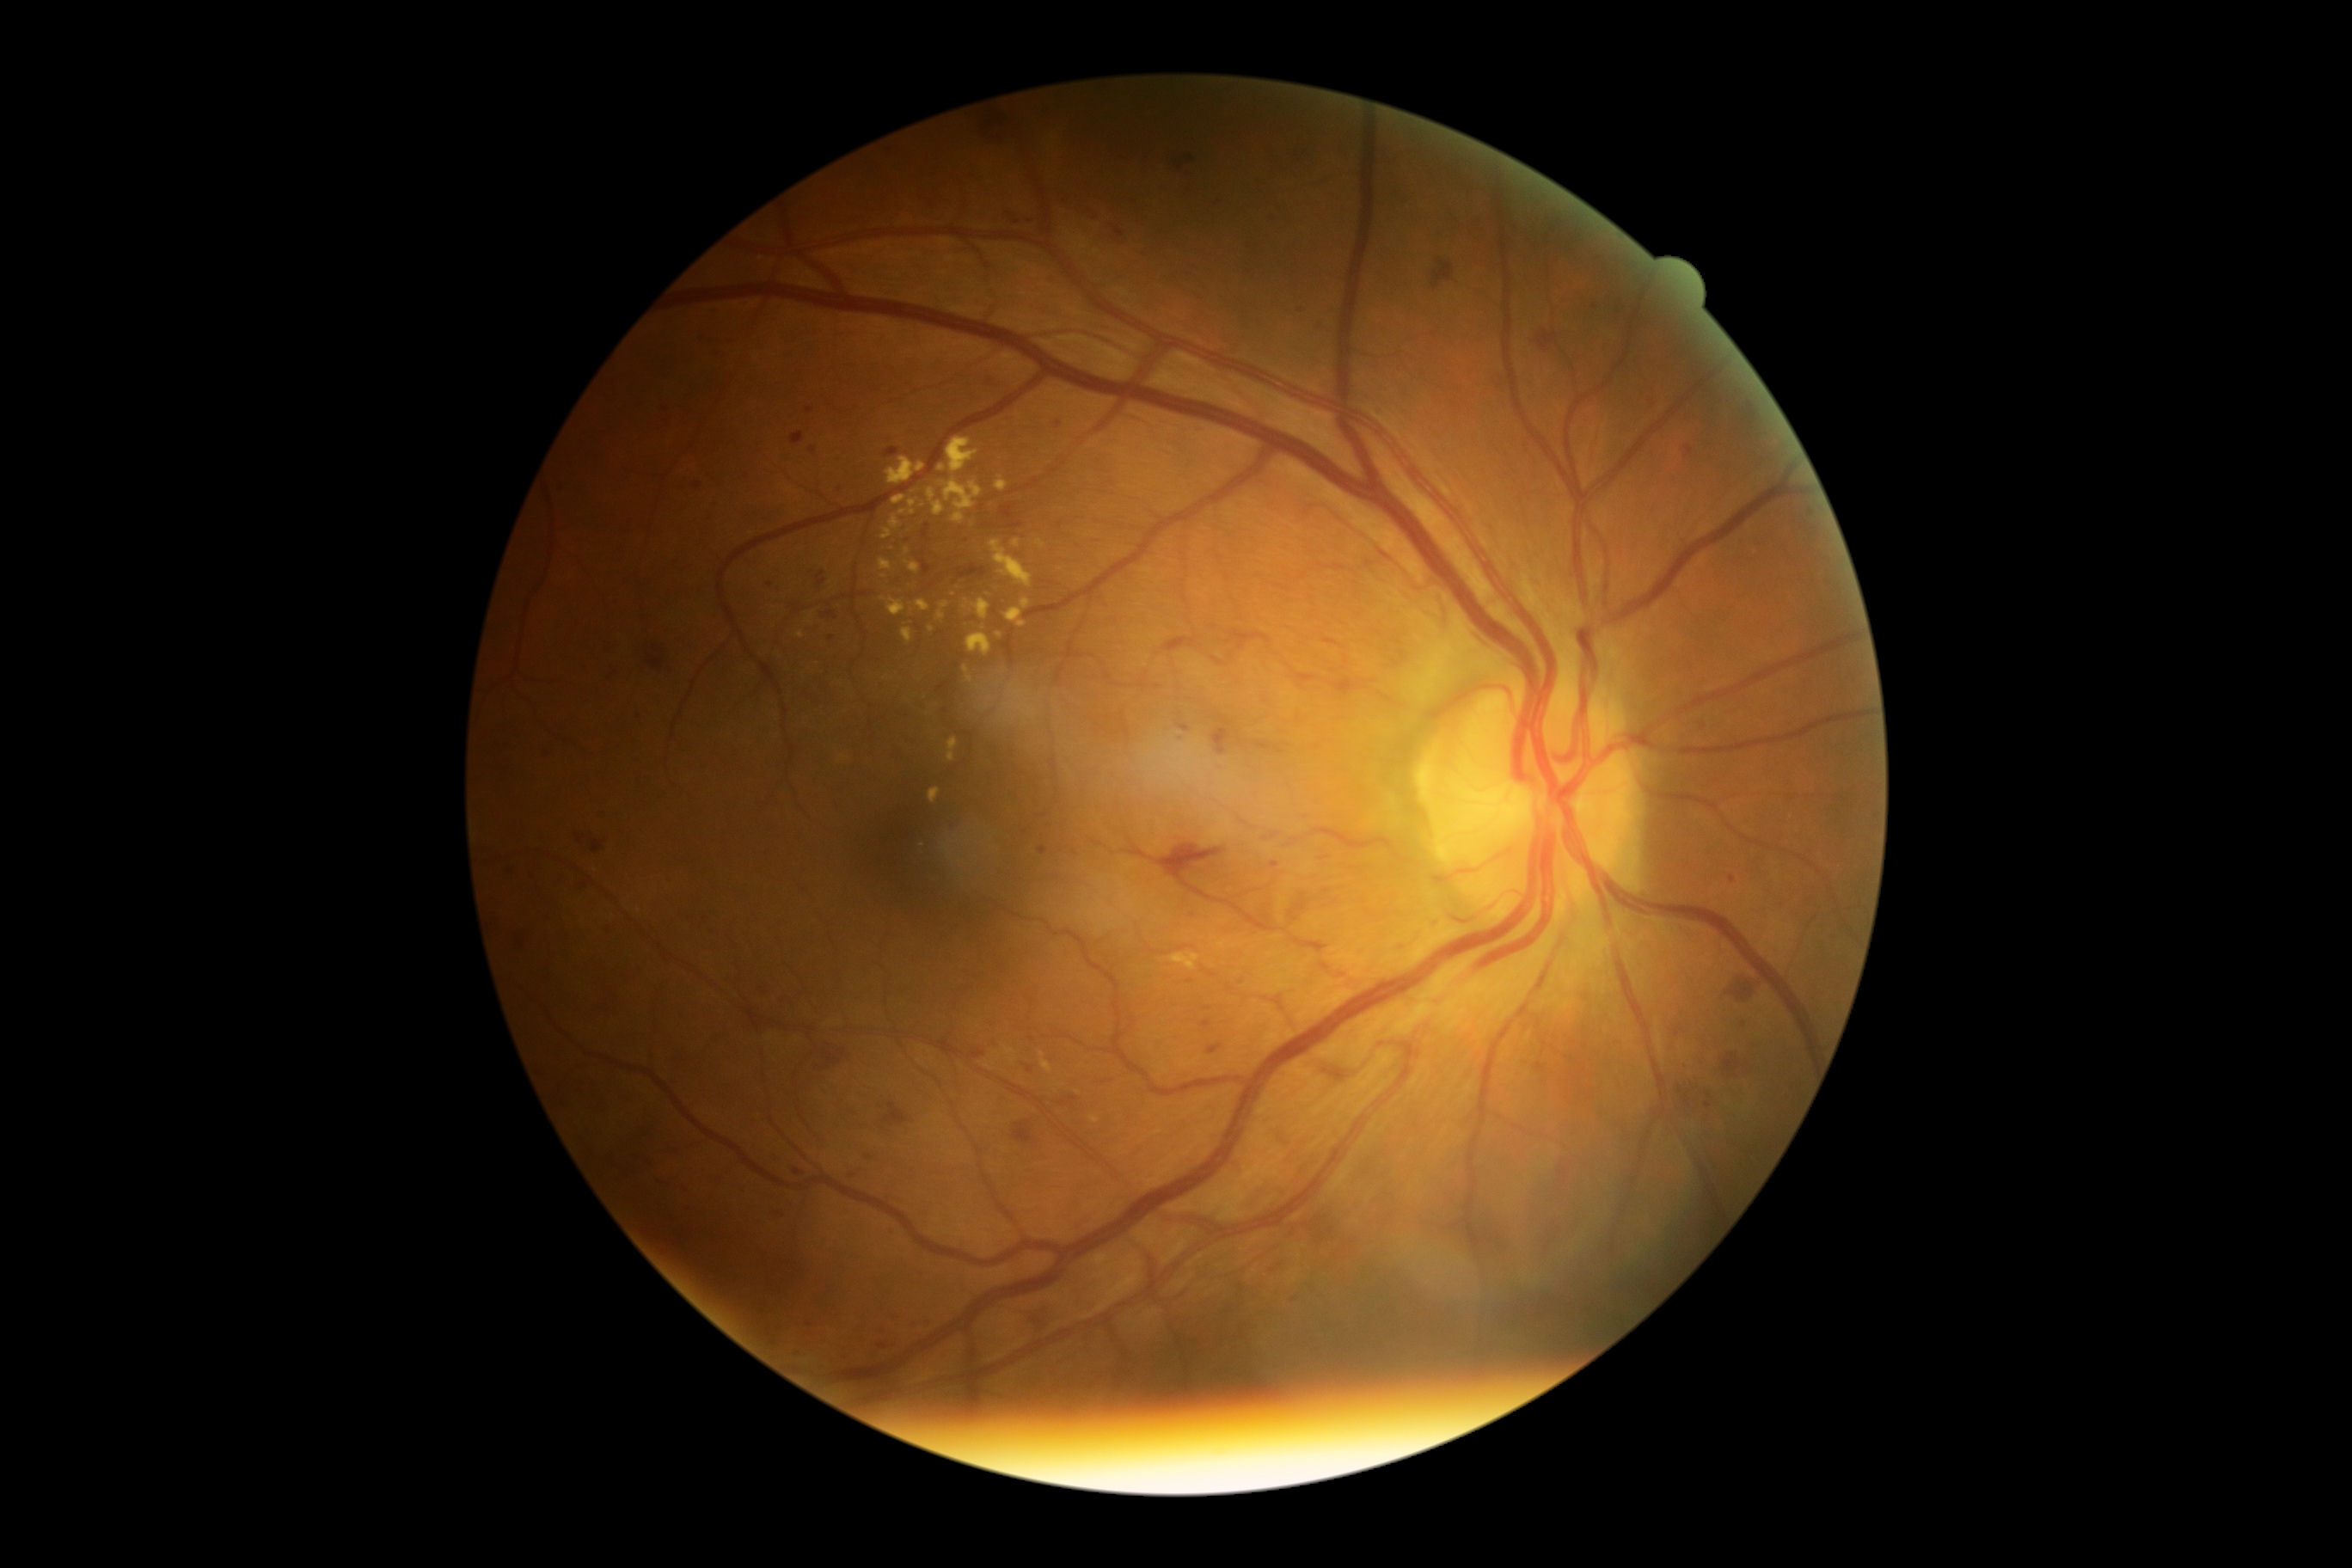
DR stage: grade 3 — more than 20 intraretinal hemorrhages in each of 4 quadrants, definite venous beading in 2 or more quadrants, or prominent intraretinal microvascular abnormalities in 1 or more quadrants, with no signs of proliferative retinopathy.